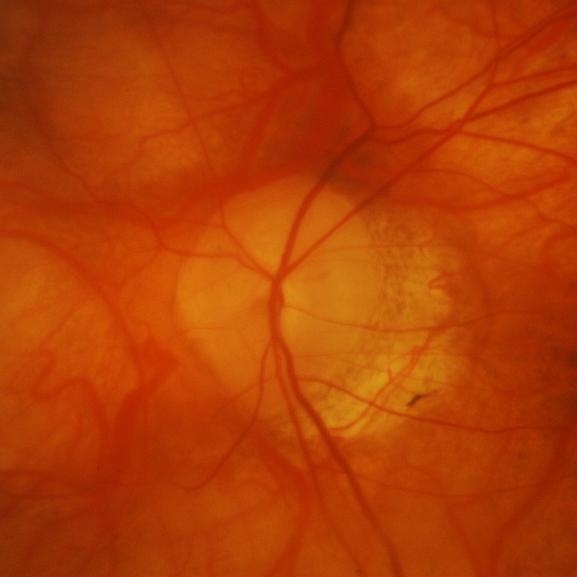
Q: Is there glaucomatous optic neuropathy?
A: Glaucomatous optic neuropathy.